Image size 2048x1536.
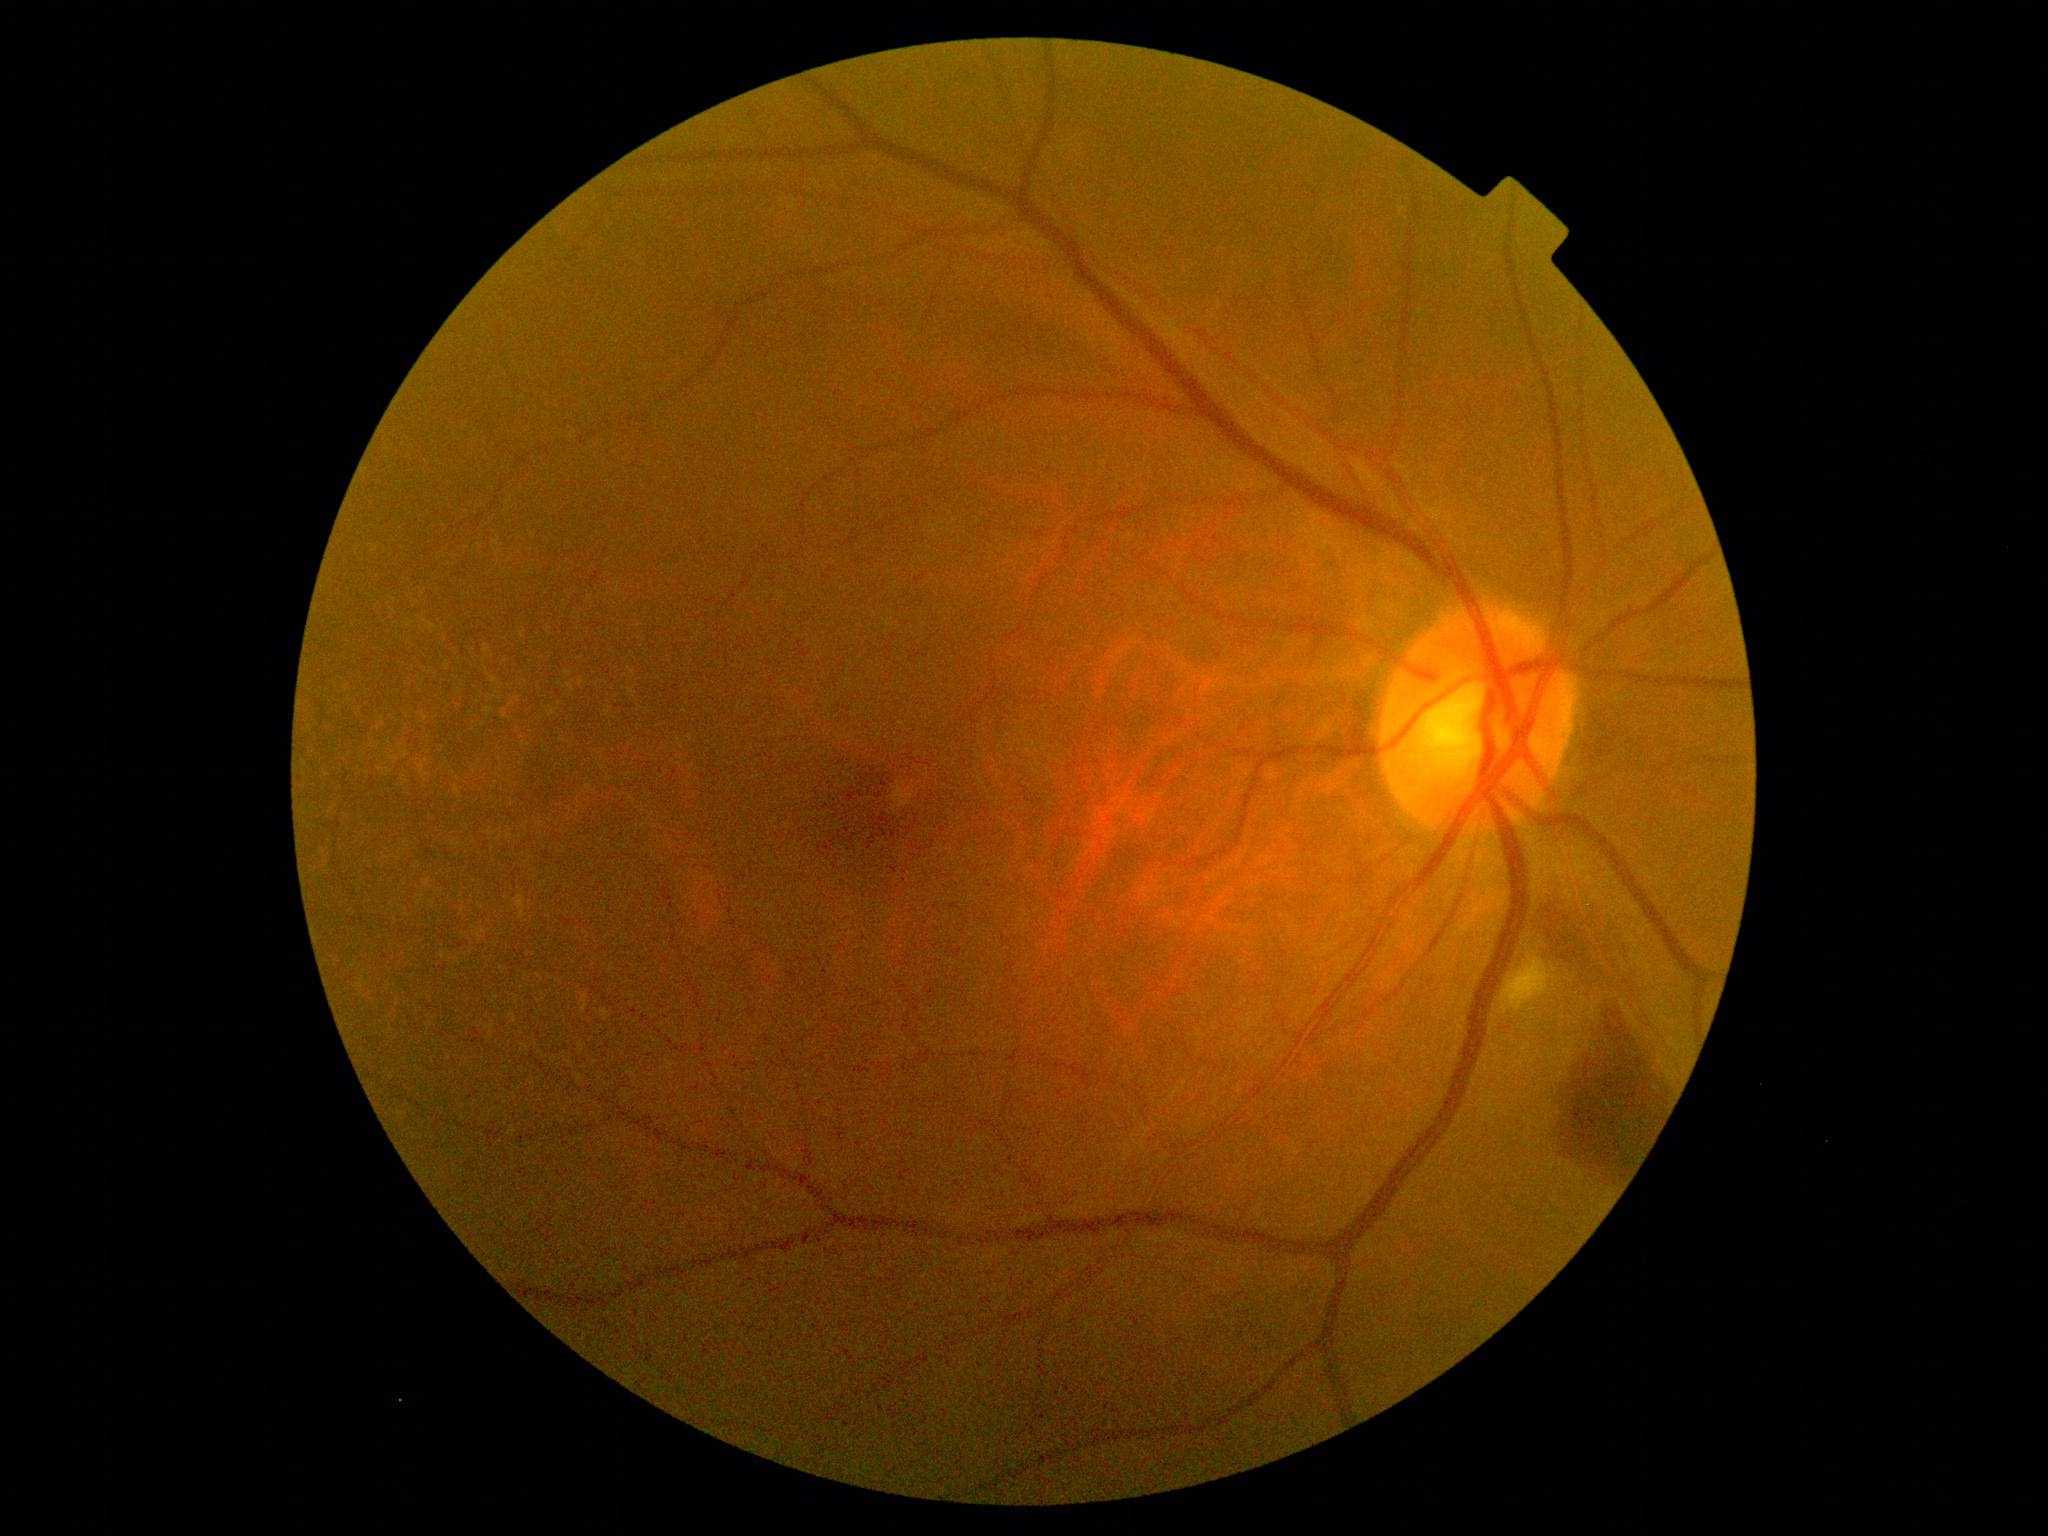
The retinopathy is classified as non-proliferative diabetic retinopathy. DR severity: 2/4.